Infant wide-field retinal image:
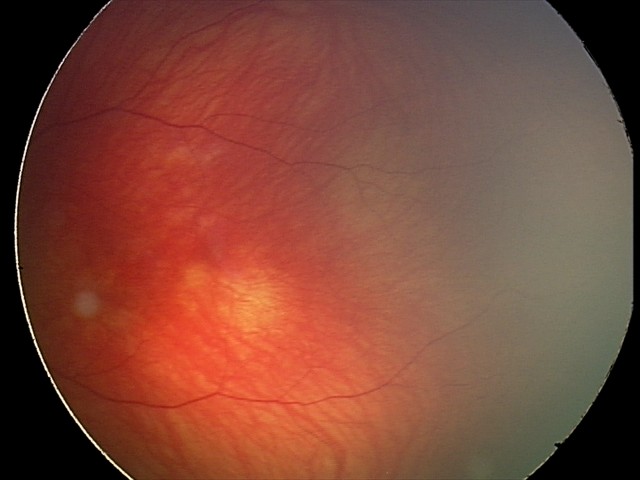
Diagnosis from this screening exam: retinal hemorrhages.